45 degree fundus photograph, nonmydriatic, NIDEK AFC-230: 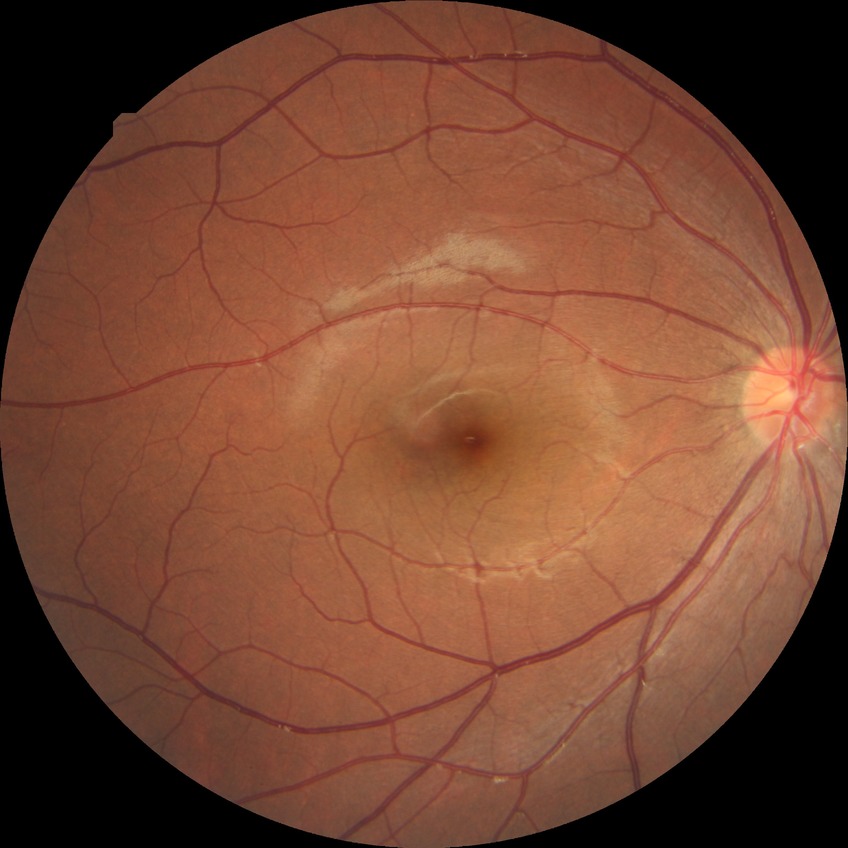
Assessment:
* modified Davis grading — no diabetic retinopathy